Pupil-dilated: 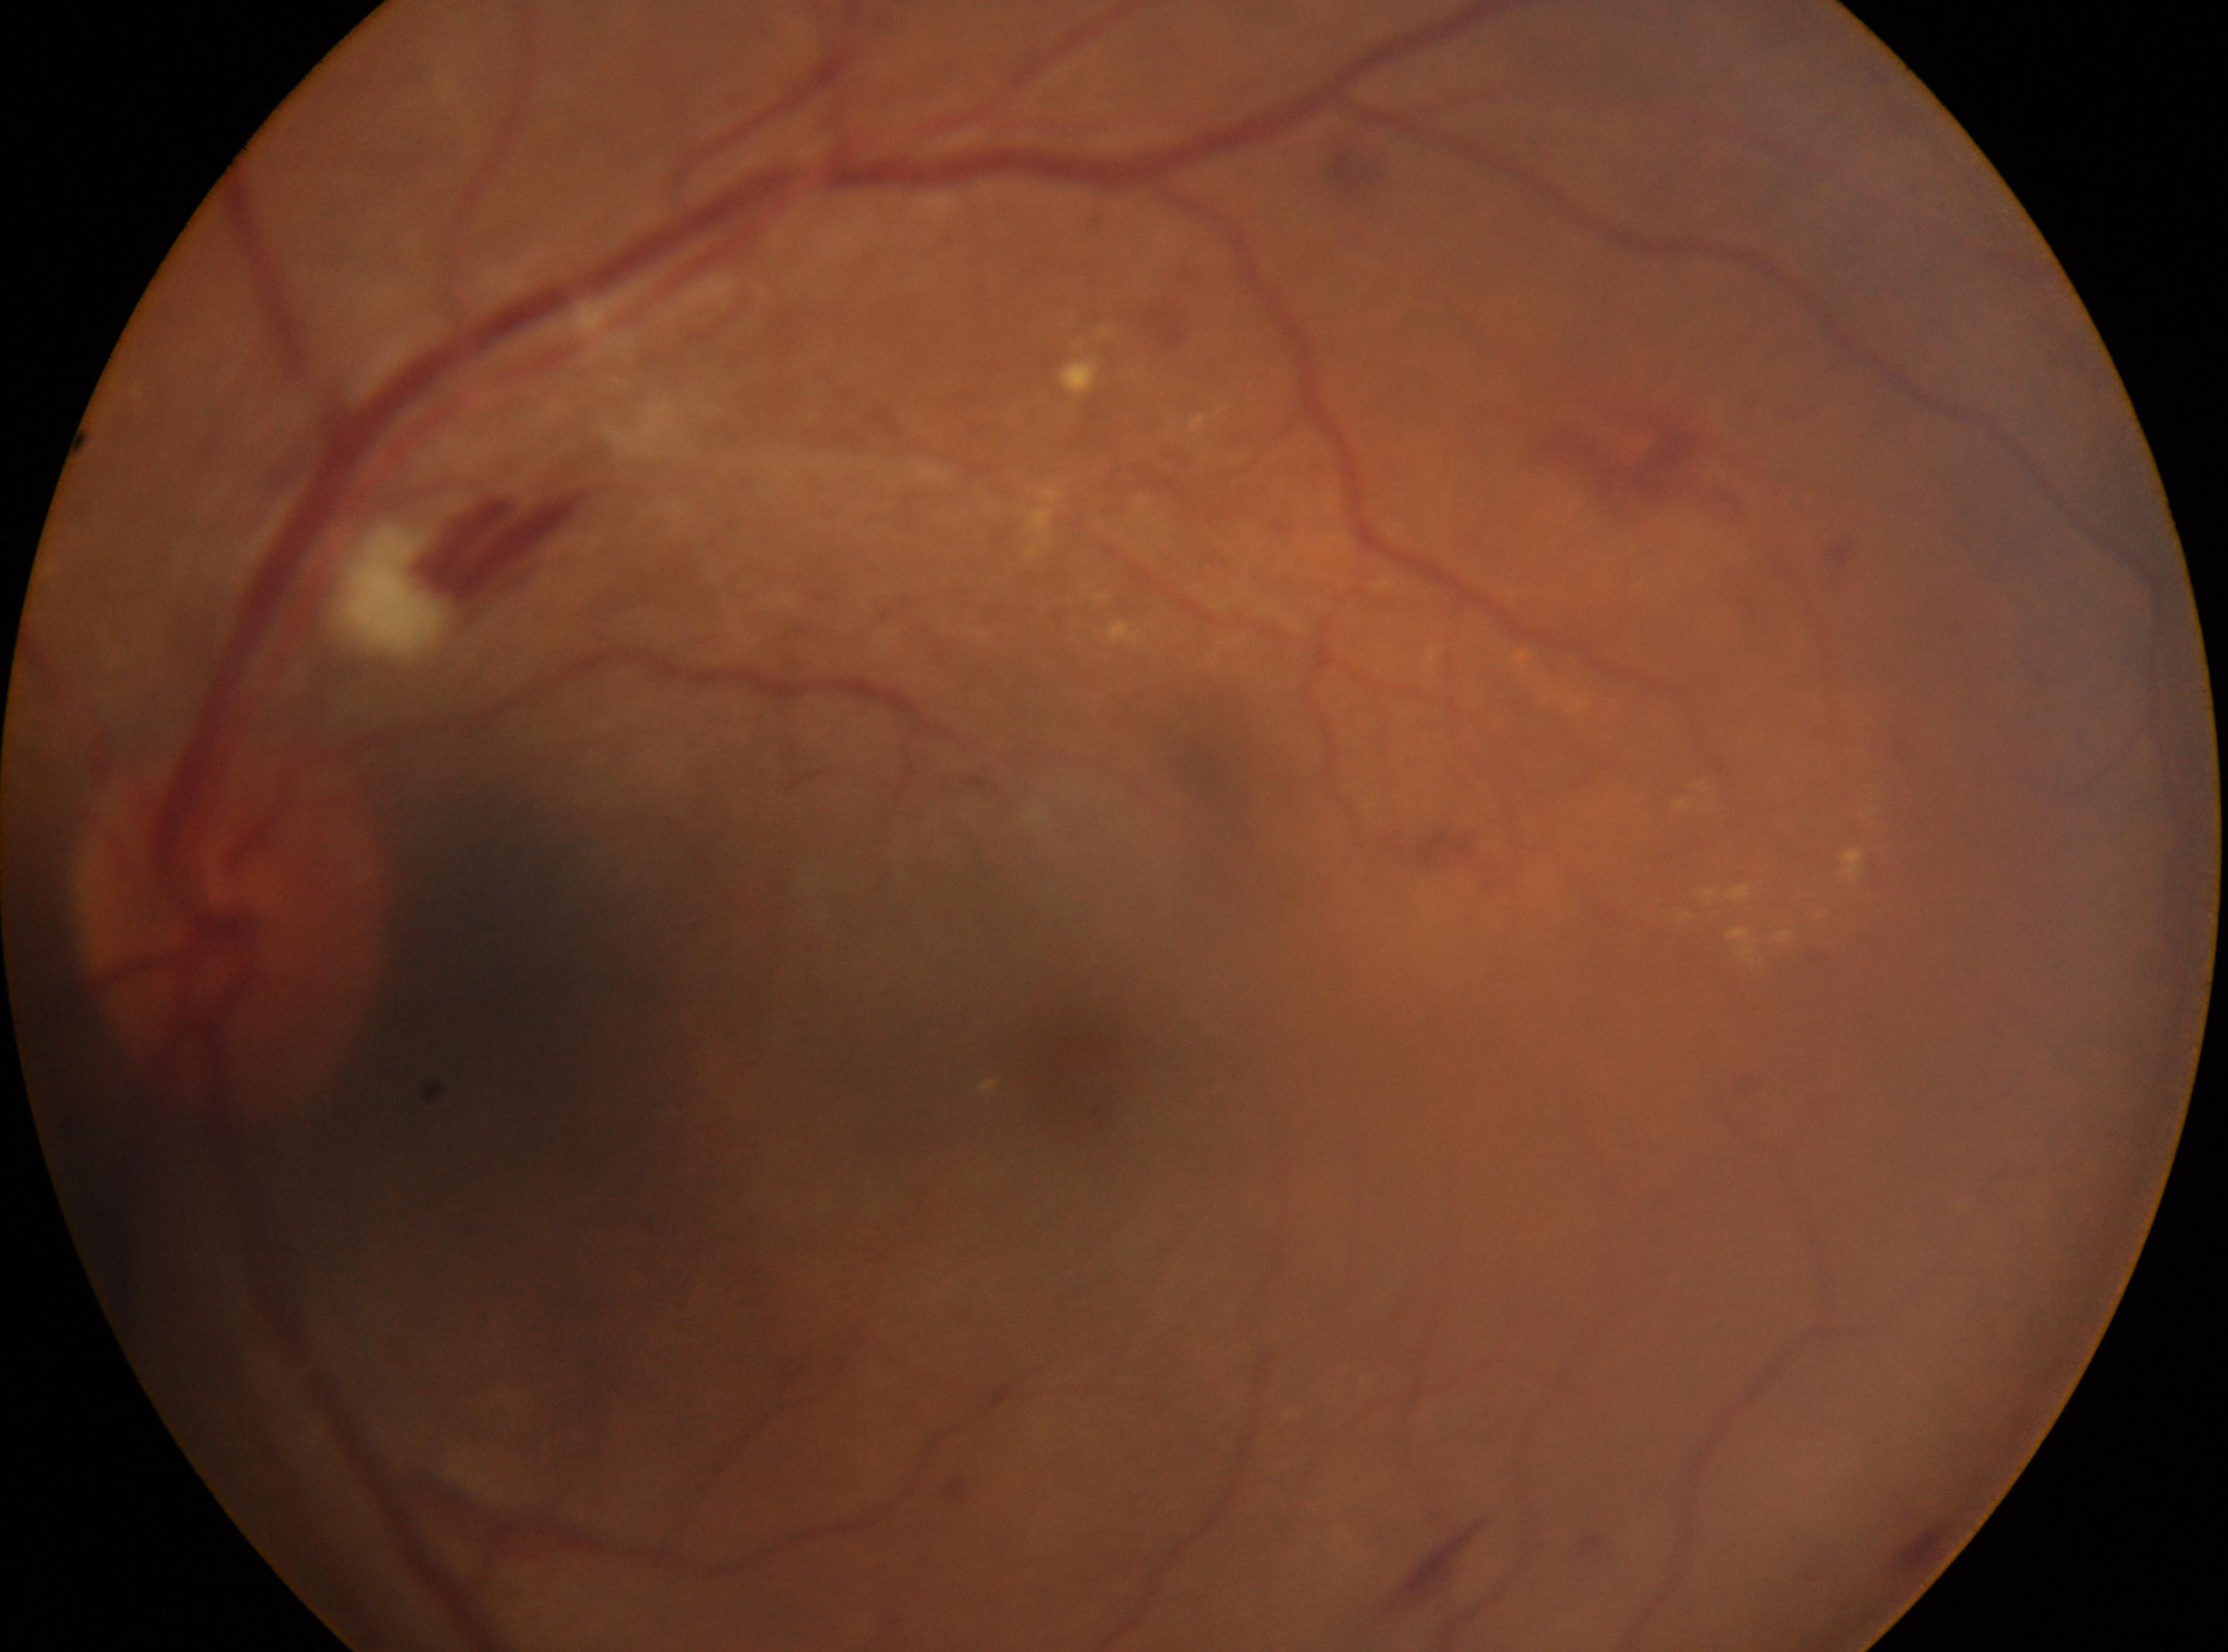
optic disc: 231, 927 | fovea center: 1080, 1073 | diabetic retinopathy (DR): grade 2 (moderate NPDR) | non-proliferative diabetic retinopathy | left eye.